Image size 1659x2212:
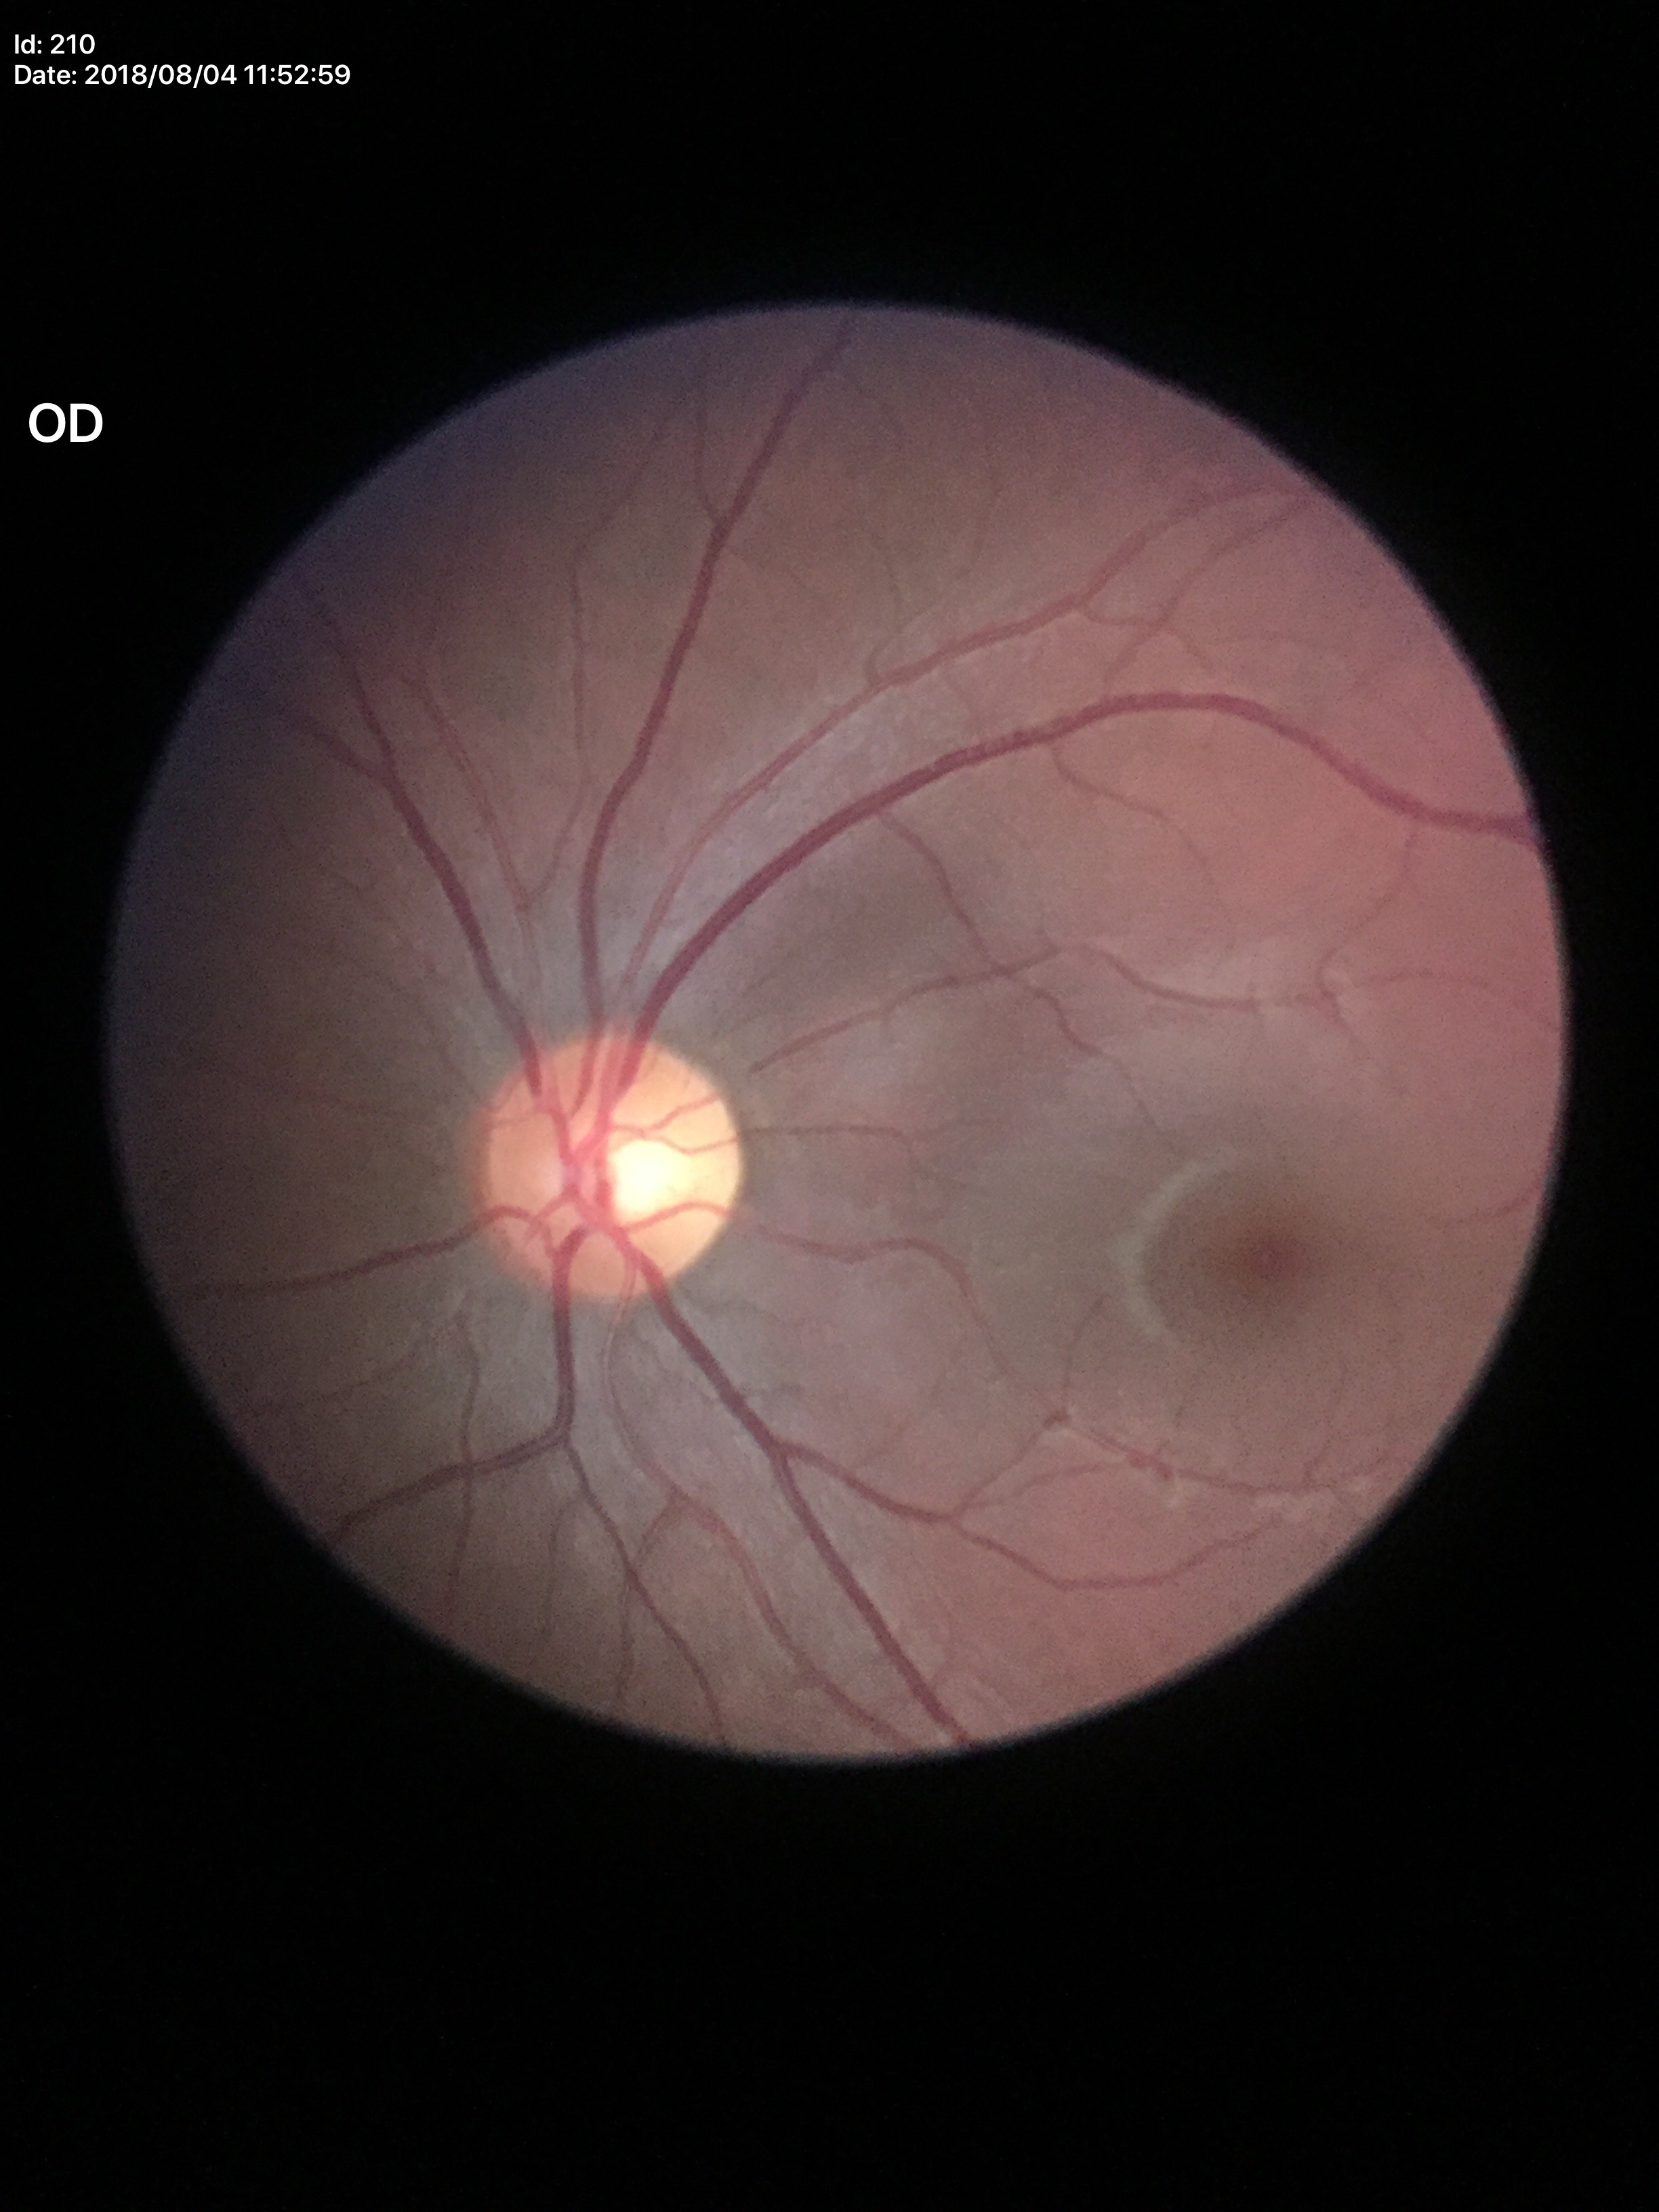
horizontal CDR = 0.56; vertical cup-disc ratio = 0.49; Glaucoma impression = not suspect.